Camera: Natus RetCam Envision (130° FOV) · 1440x1080px · pediatric retinal photograph (wide-field):
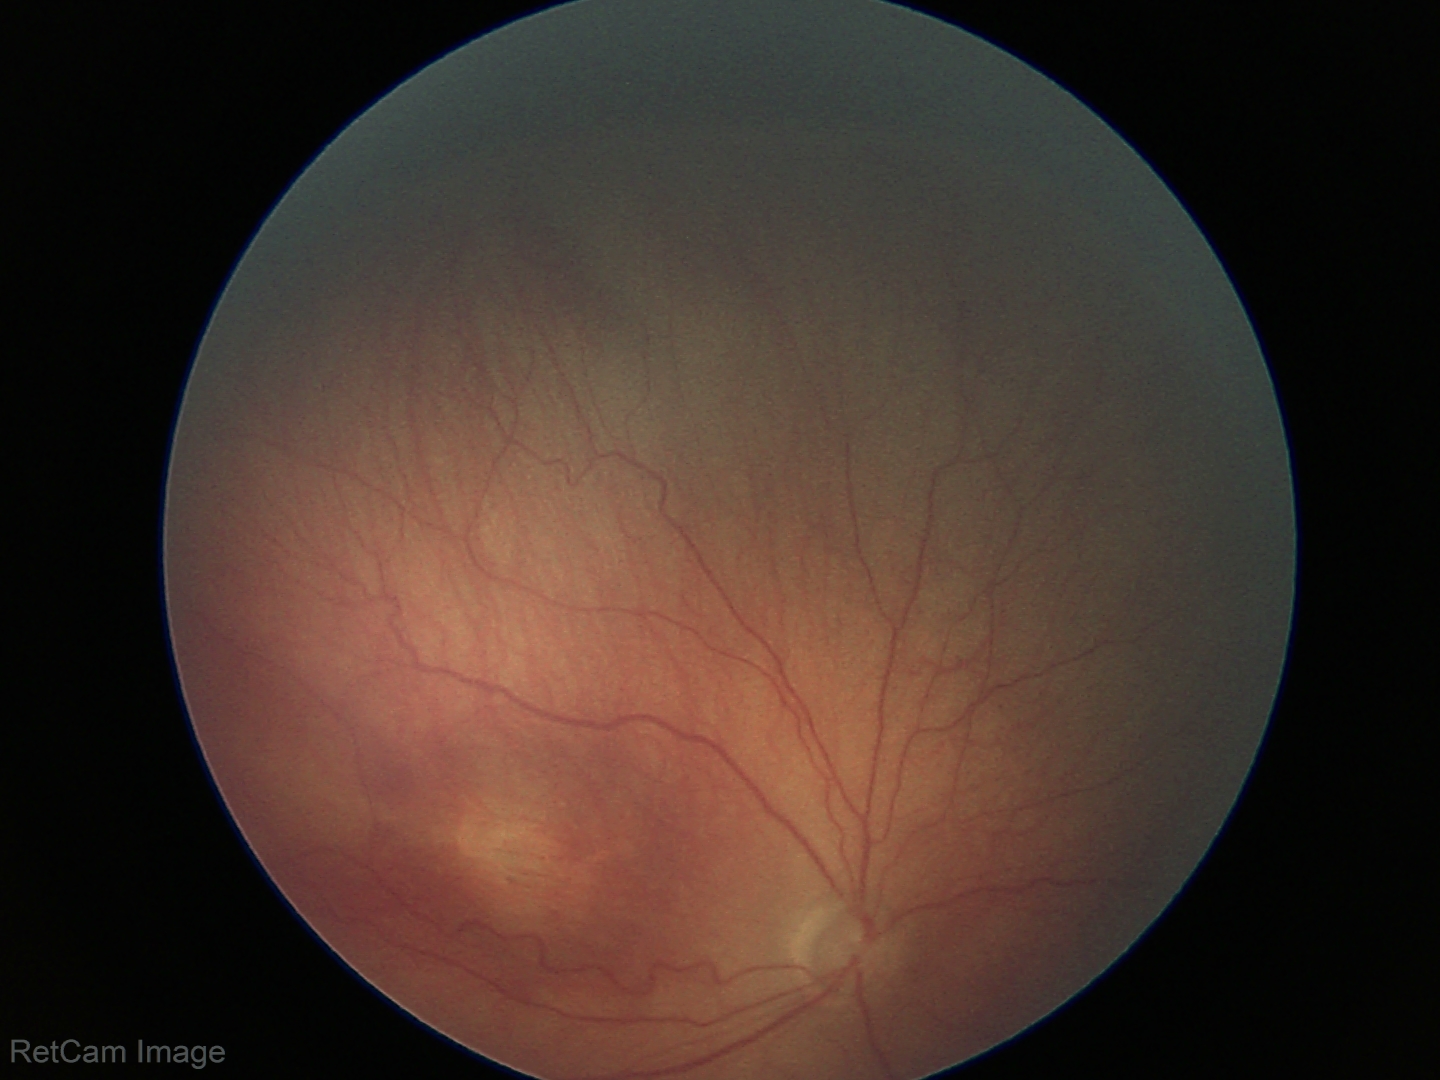

Retinopathy of prematurity (ROP) = stage 3